Image size 2352x1568; 45° field of view: 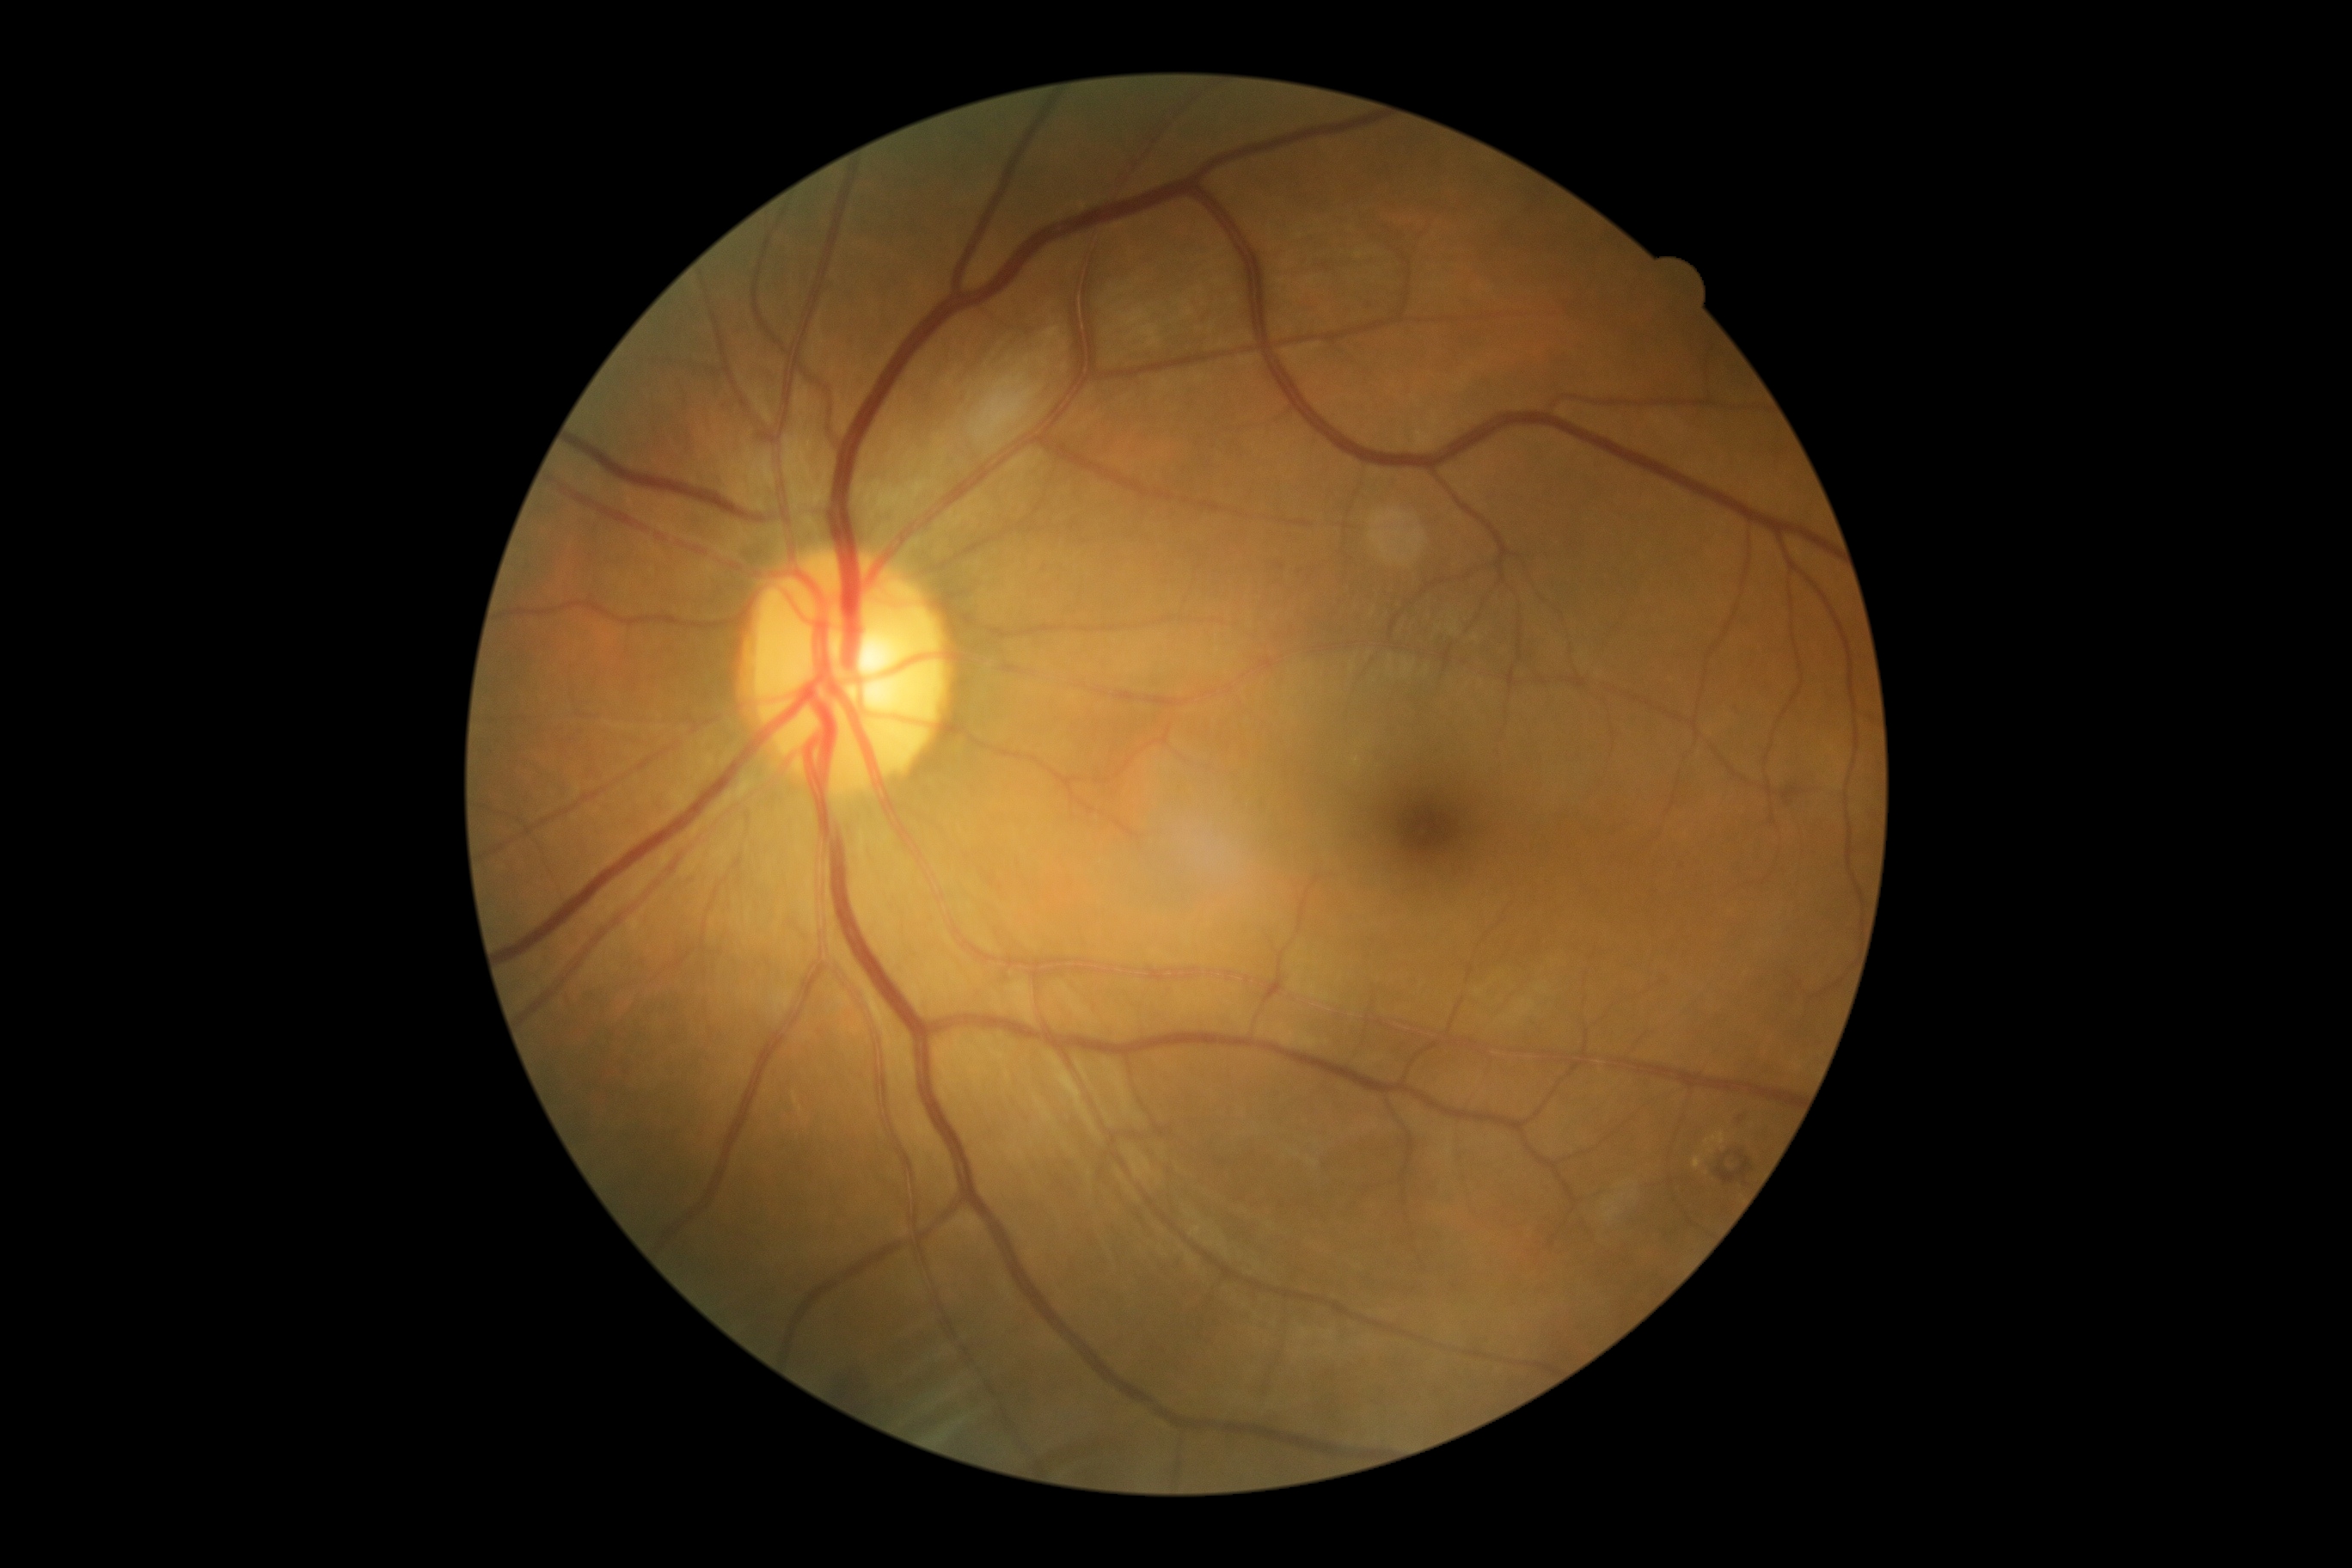

DR severity is grade 2.